Color fundus image. Image size 2352x1568
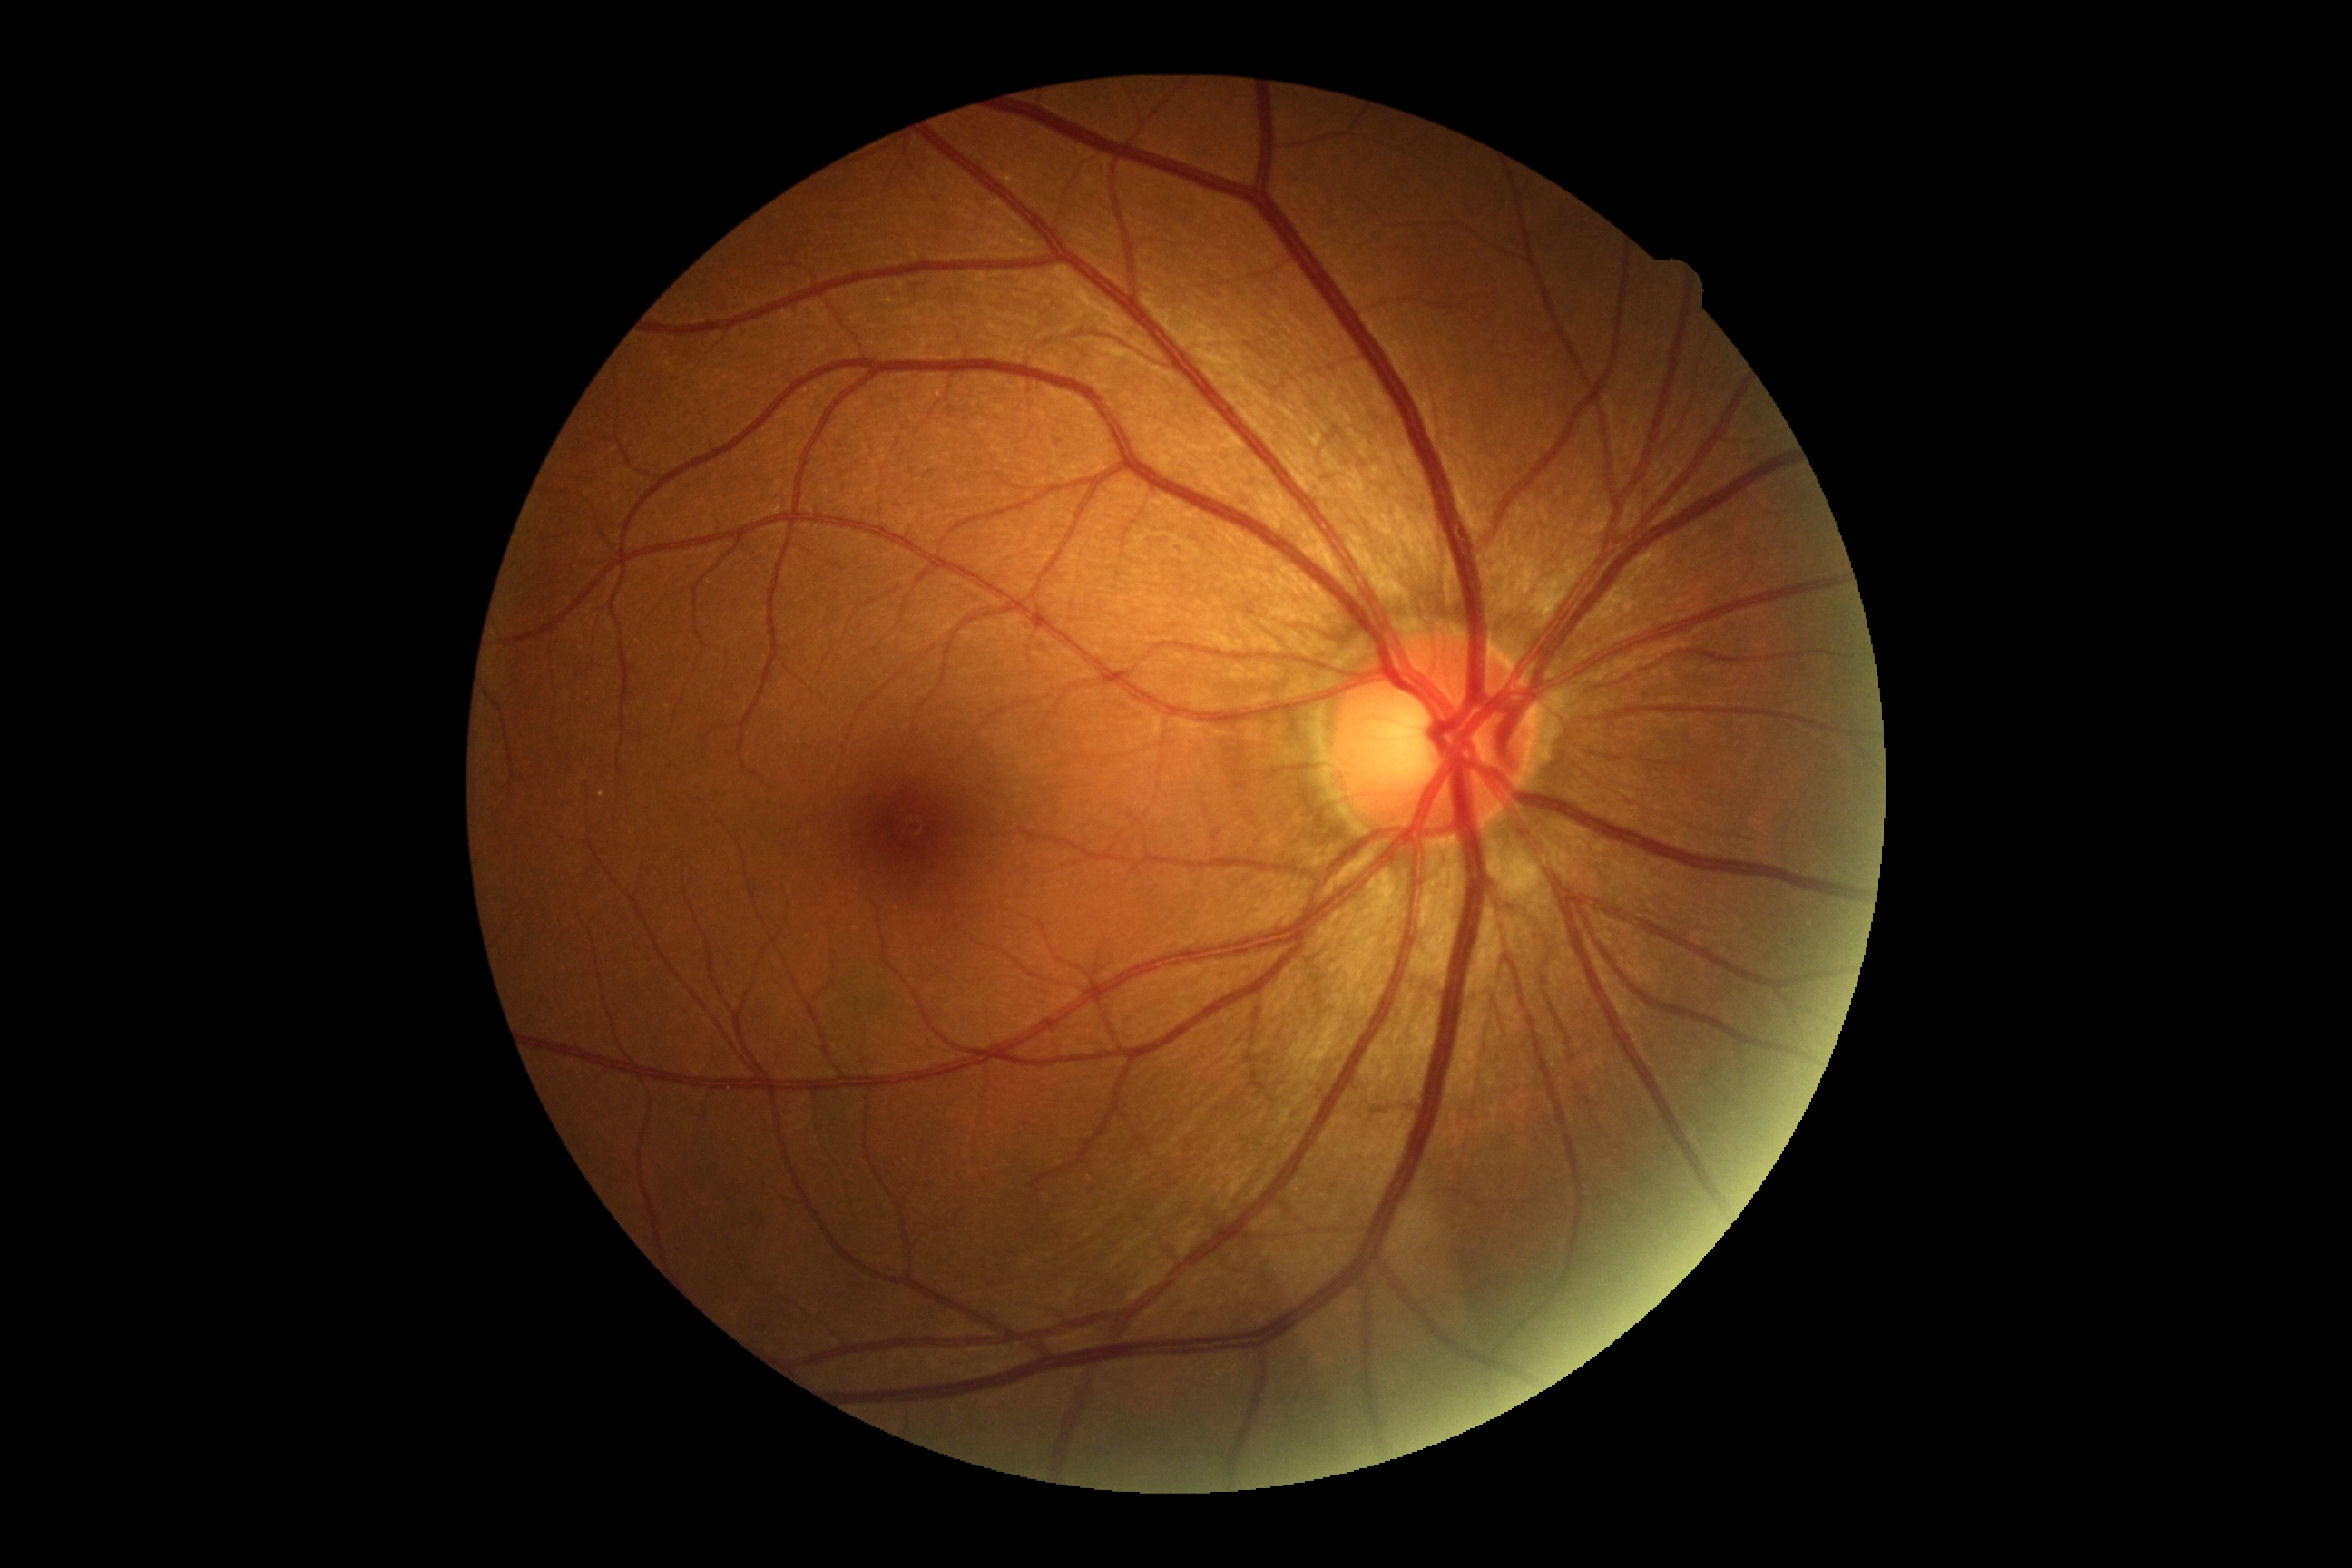

Diabetic retinopathy severity: grade 0.